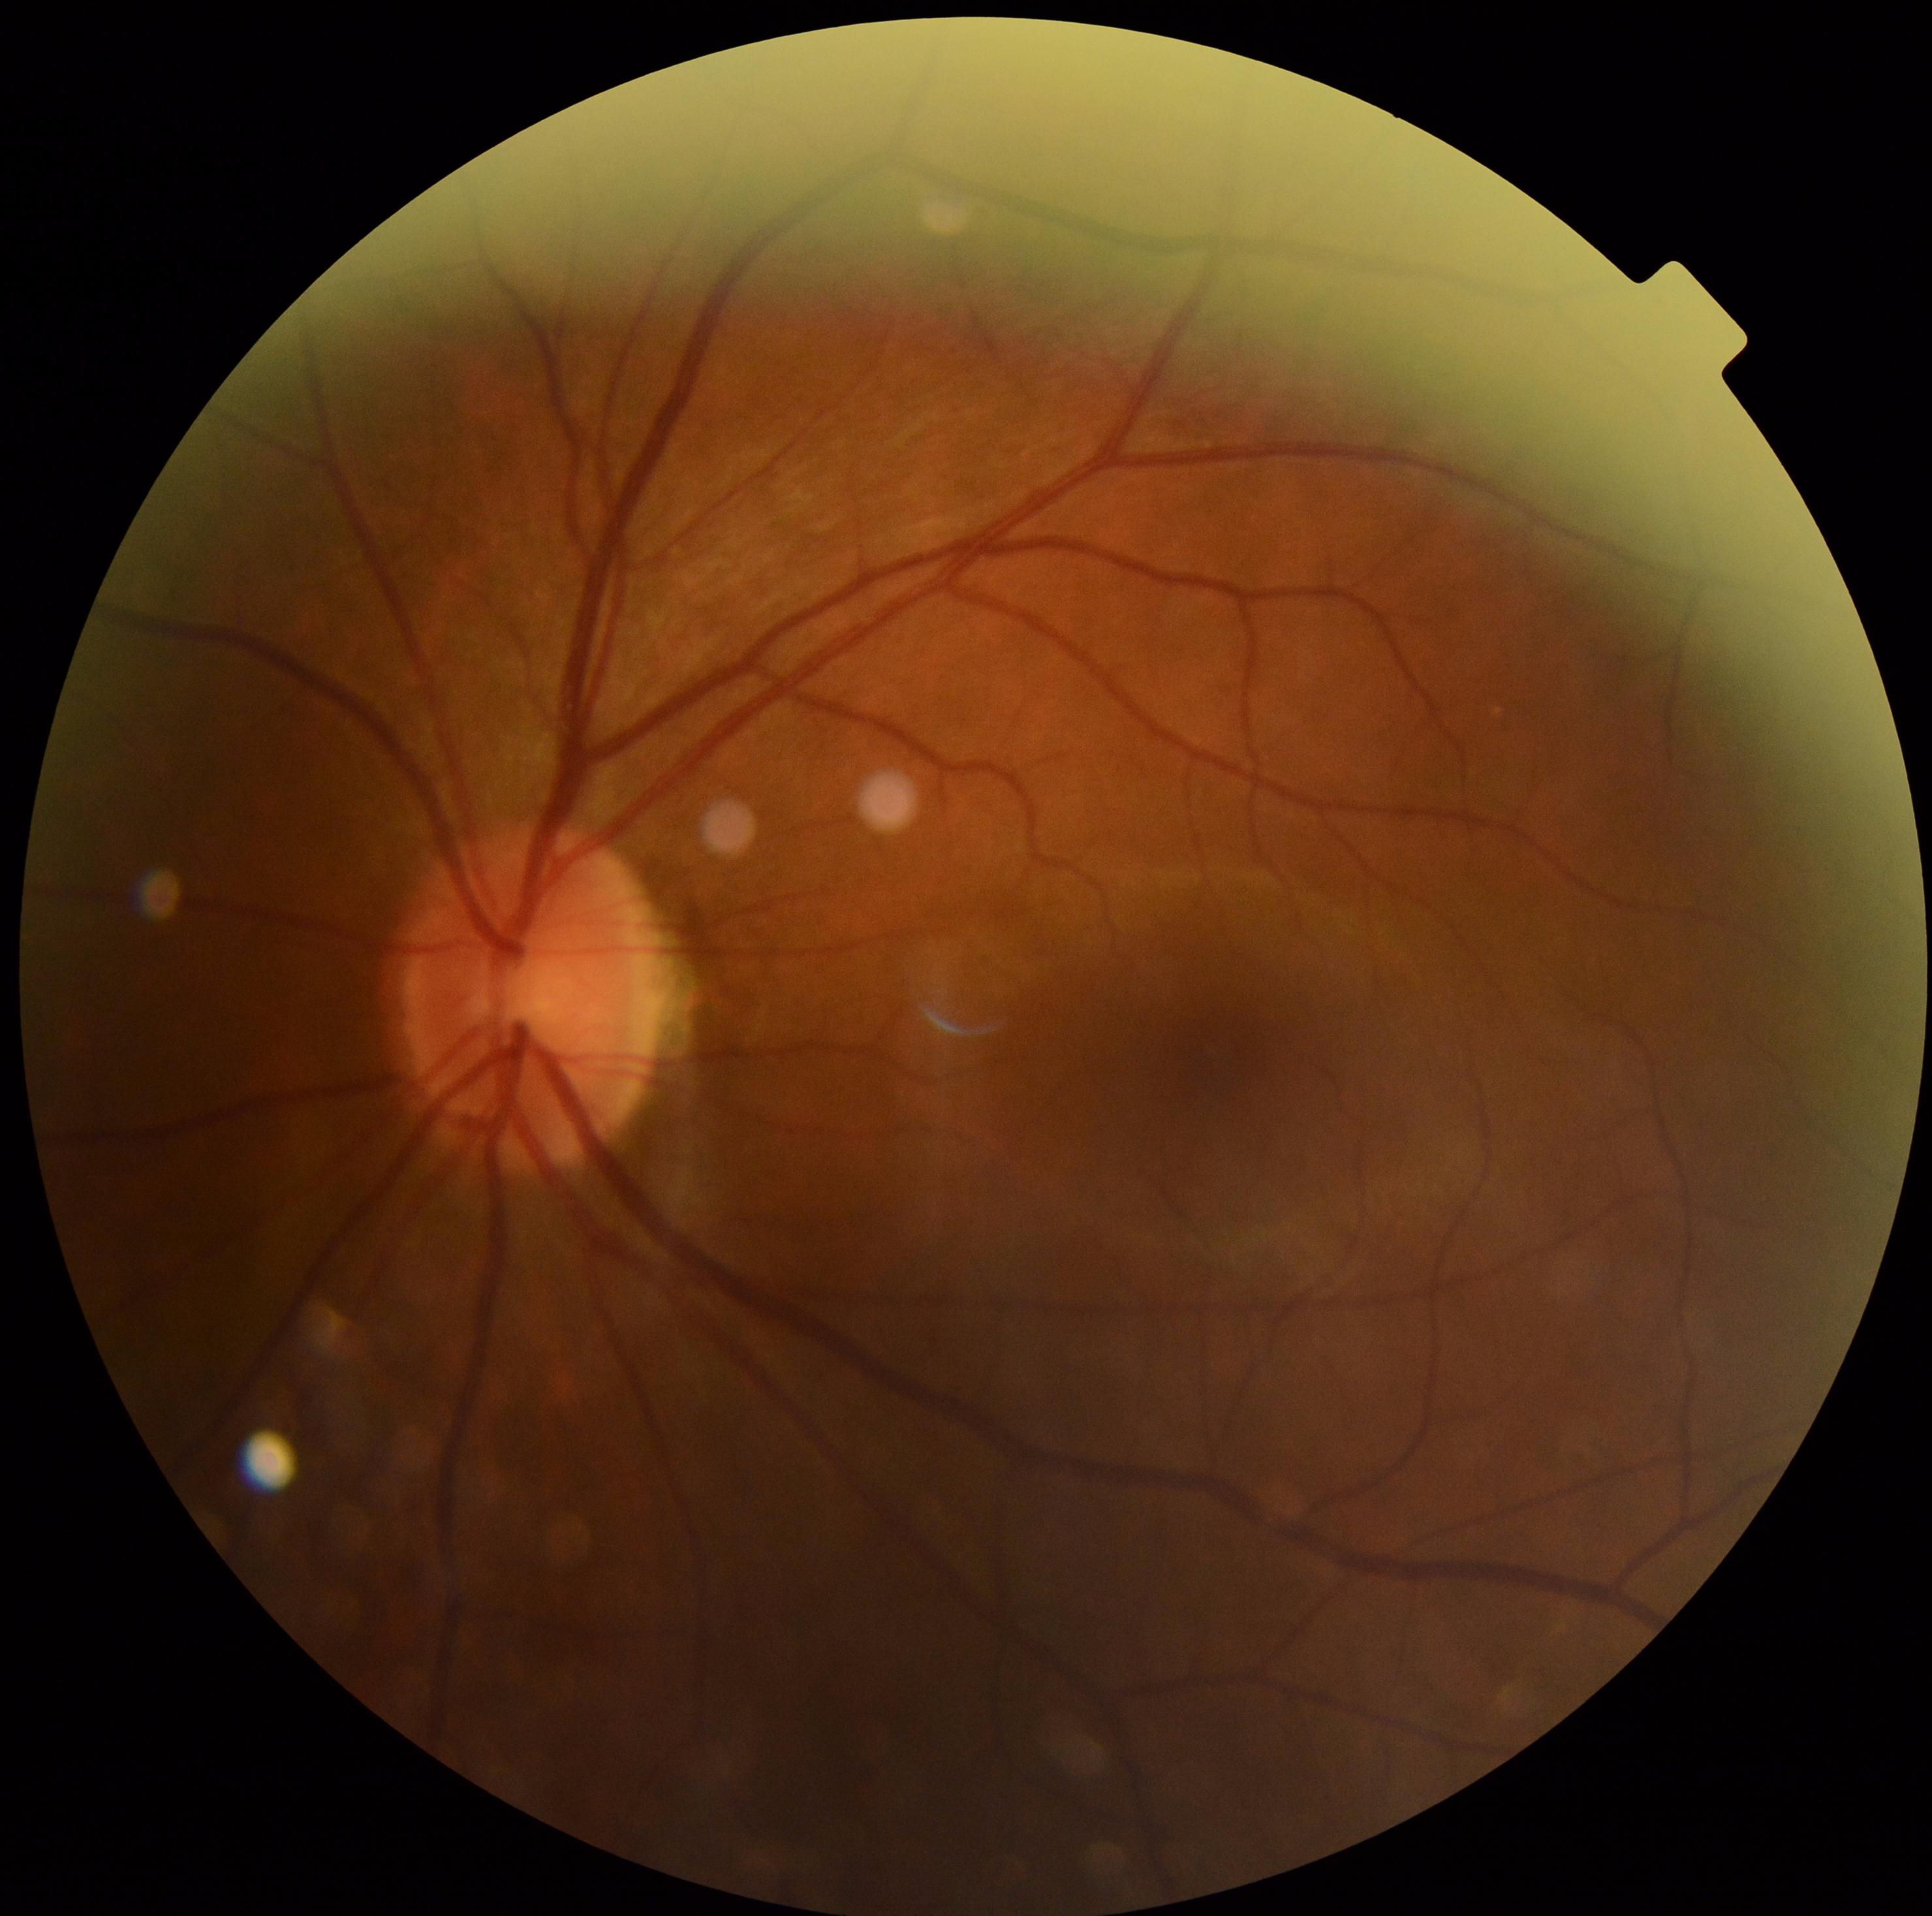

dr_grade: no apparent retinopathy (grade 0) — no visible signs of diabetic retinopathy